45-degree field of view, 1932x1910 — 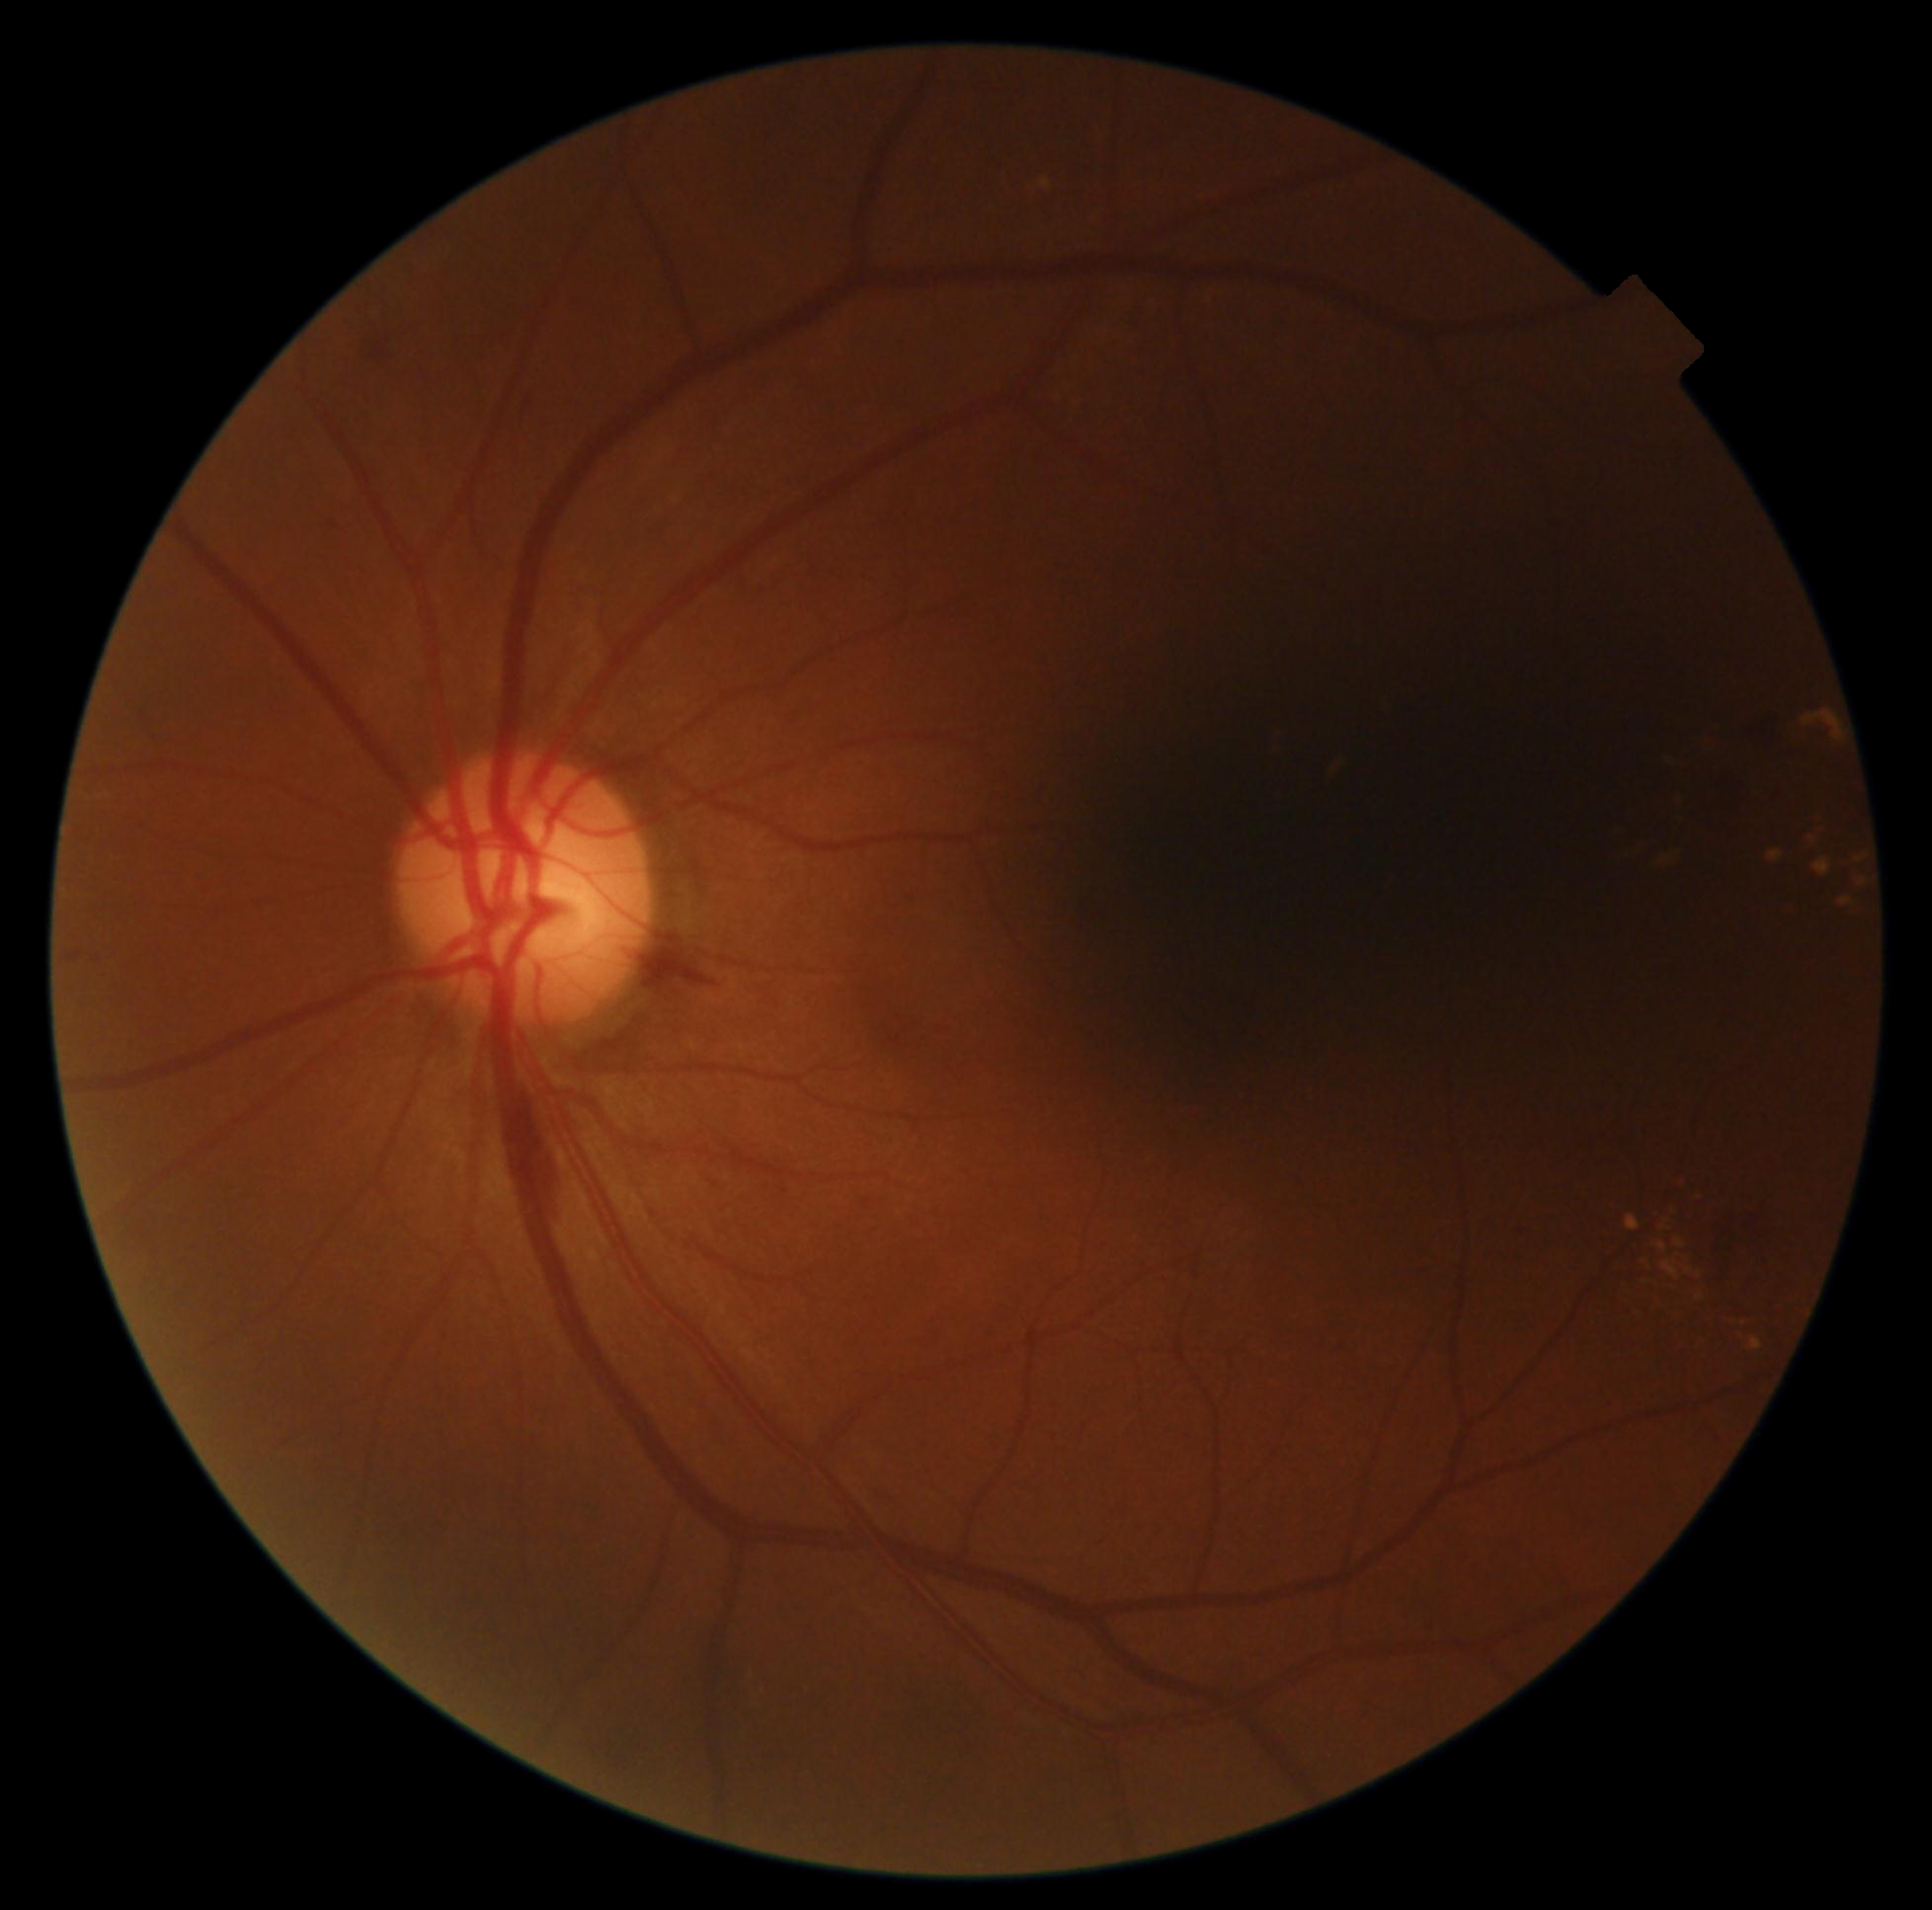
Retinopathy: 2.
DR class: non-proliferative diabetic retinopathy.